2212 by 1659 pixels — 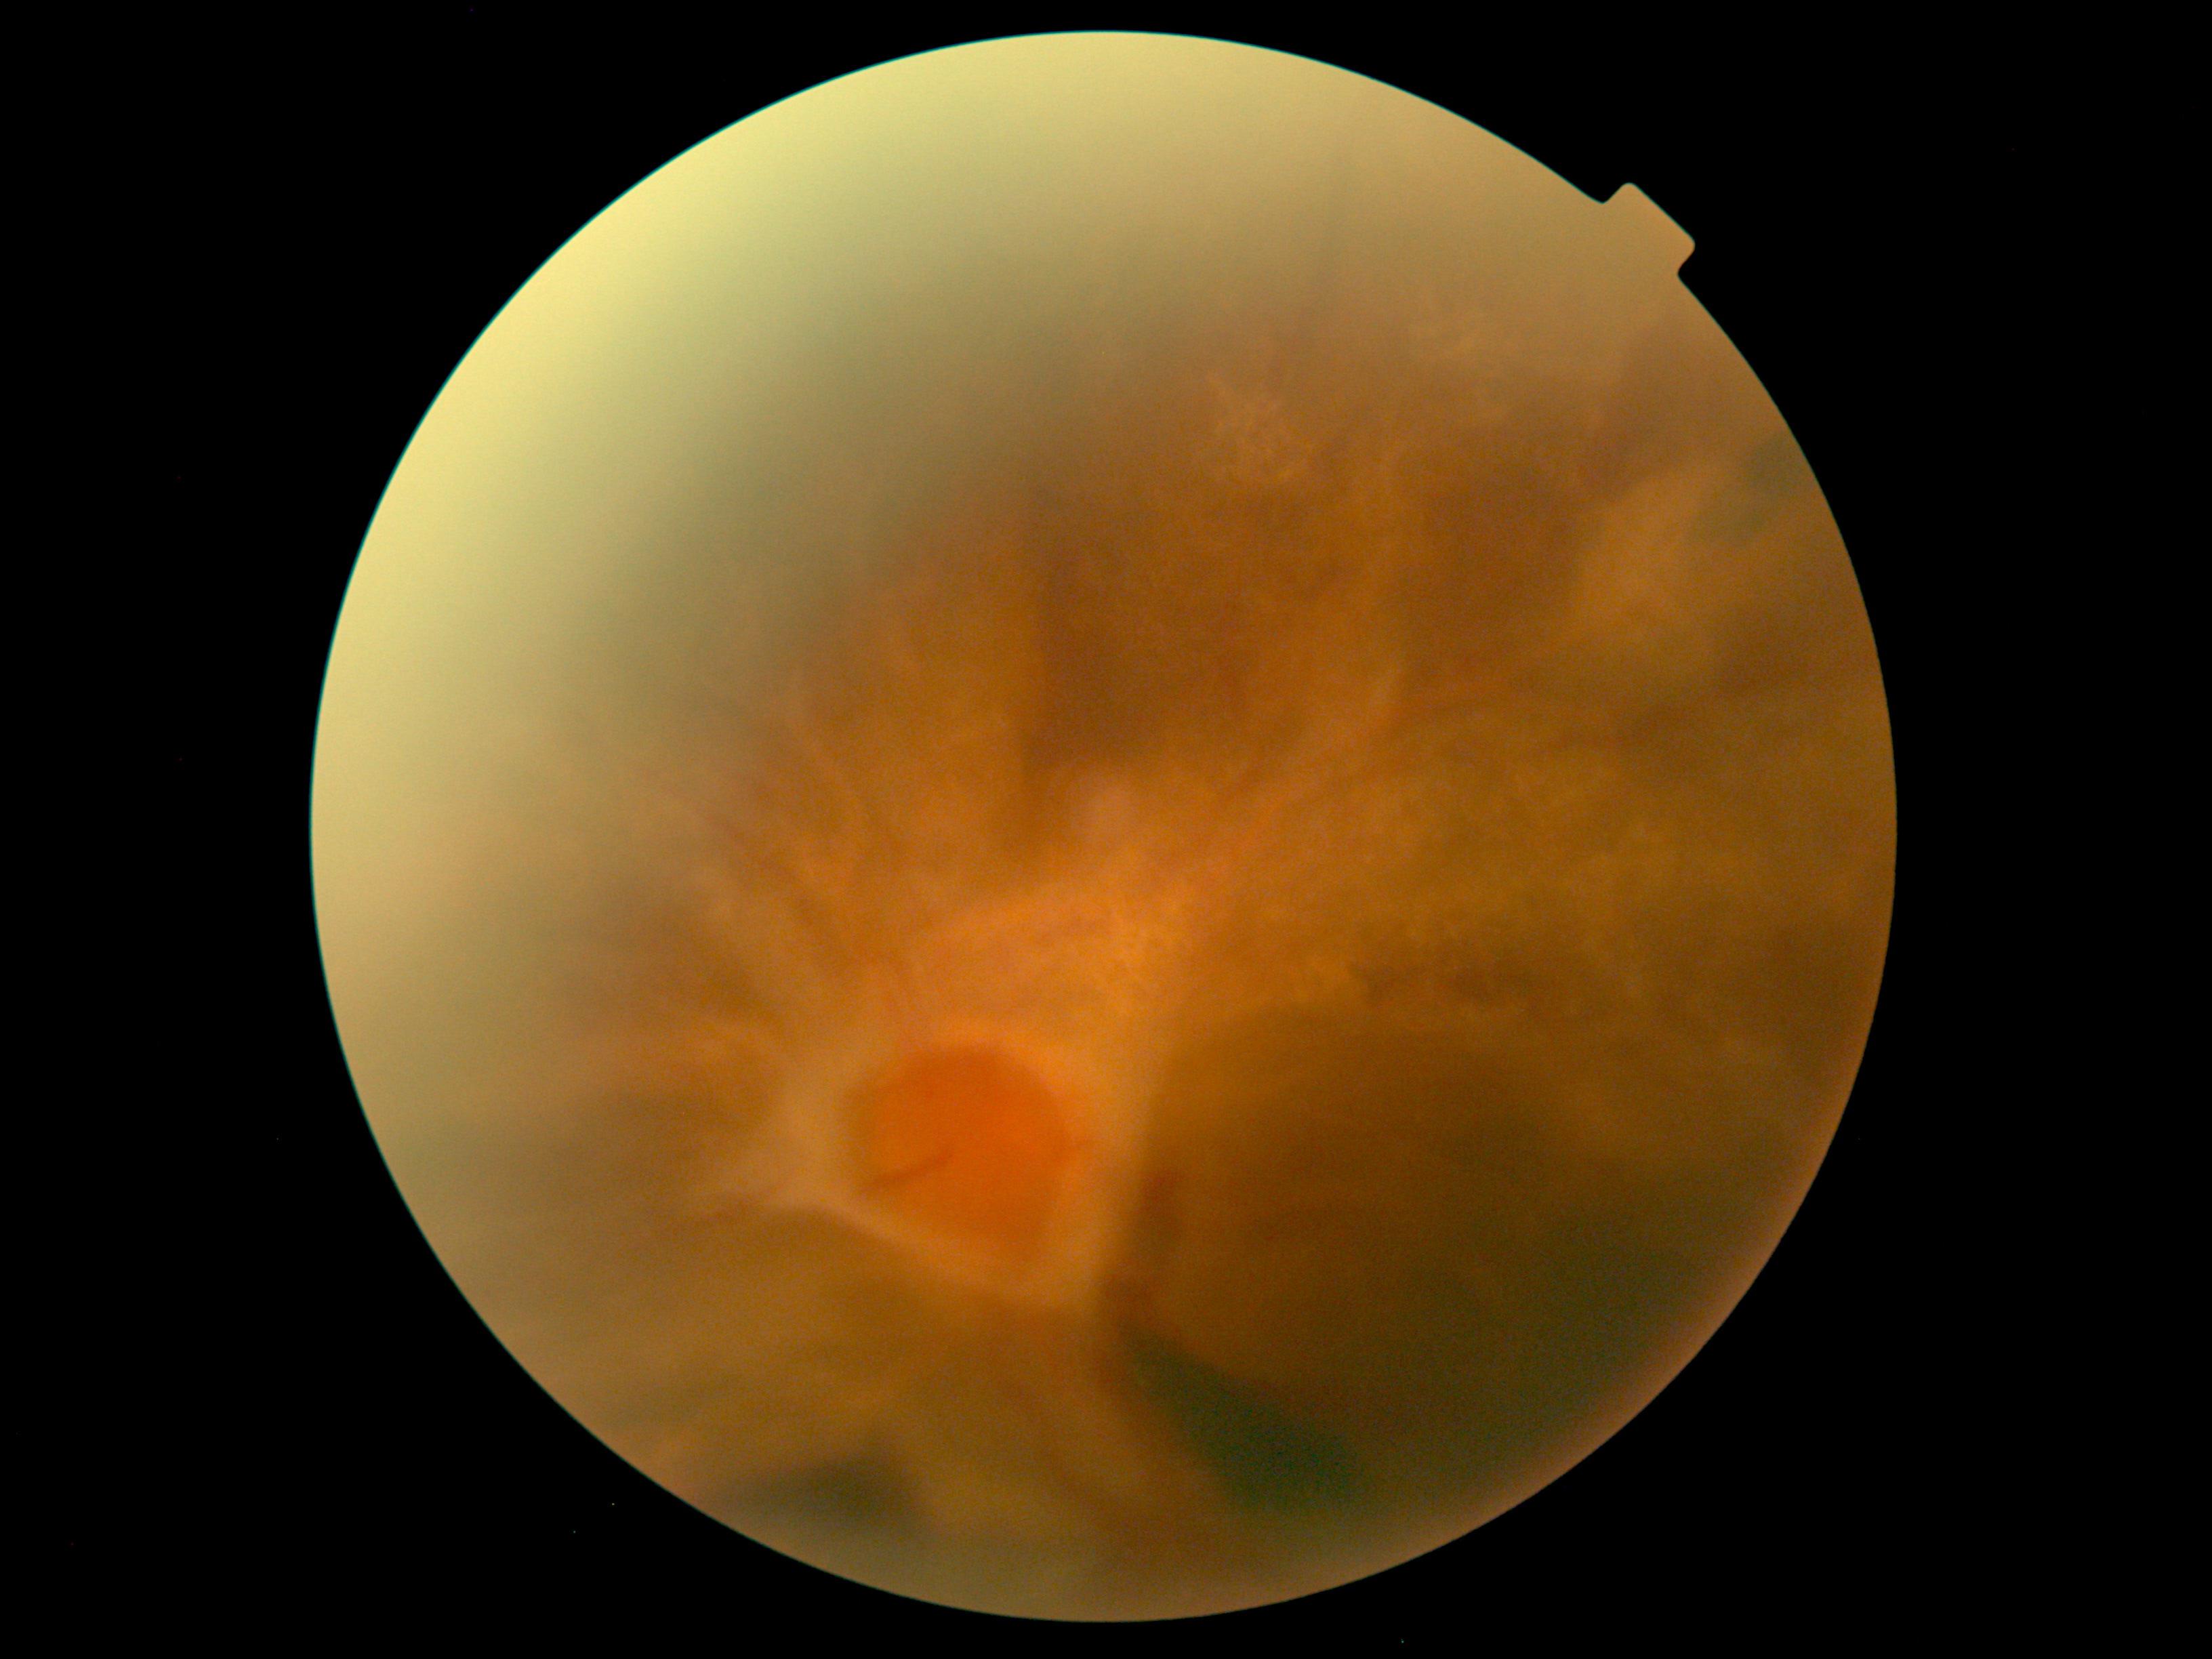

retinopathy grade=4.